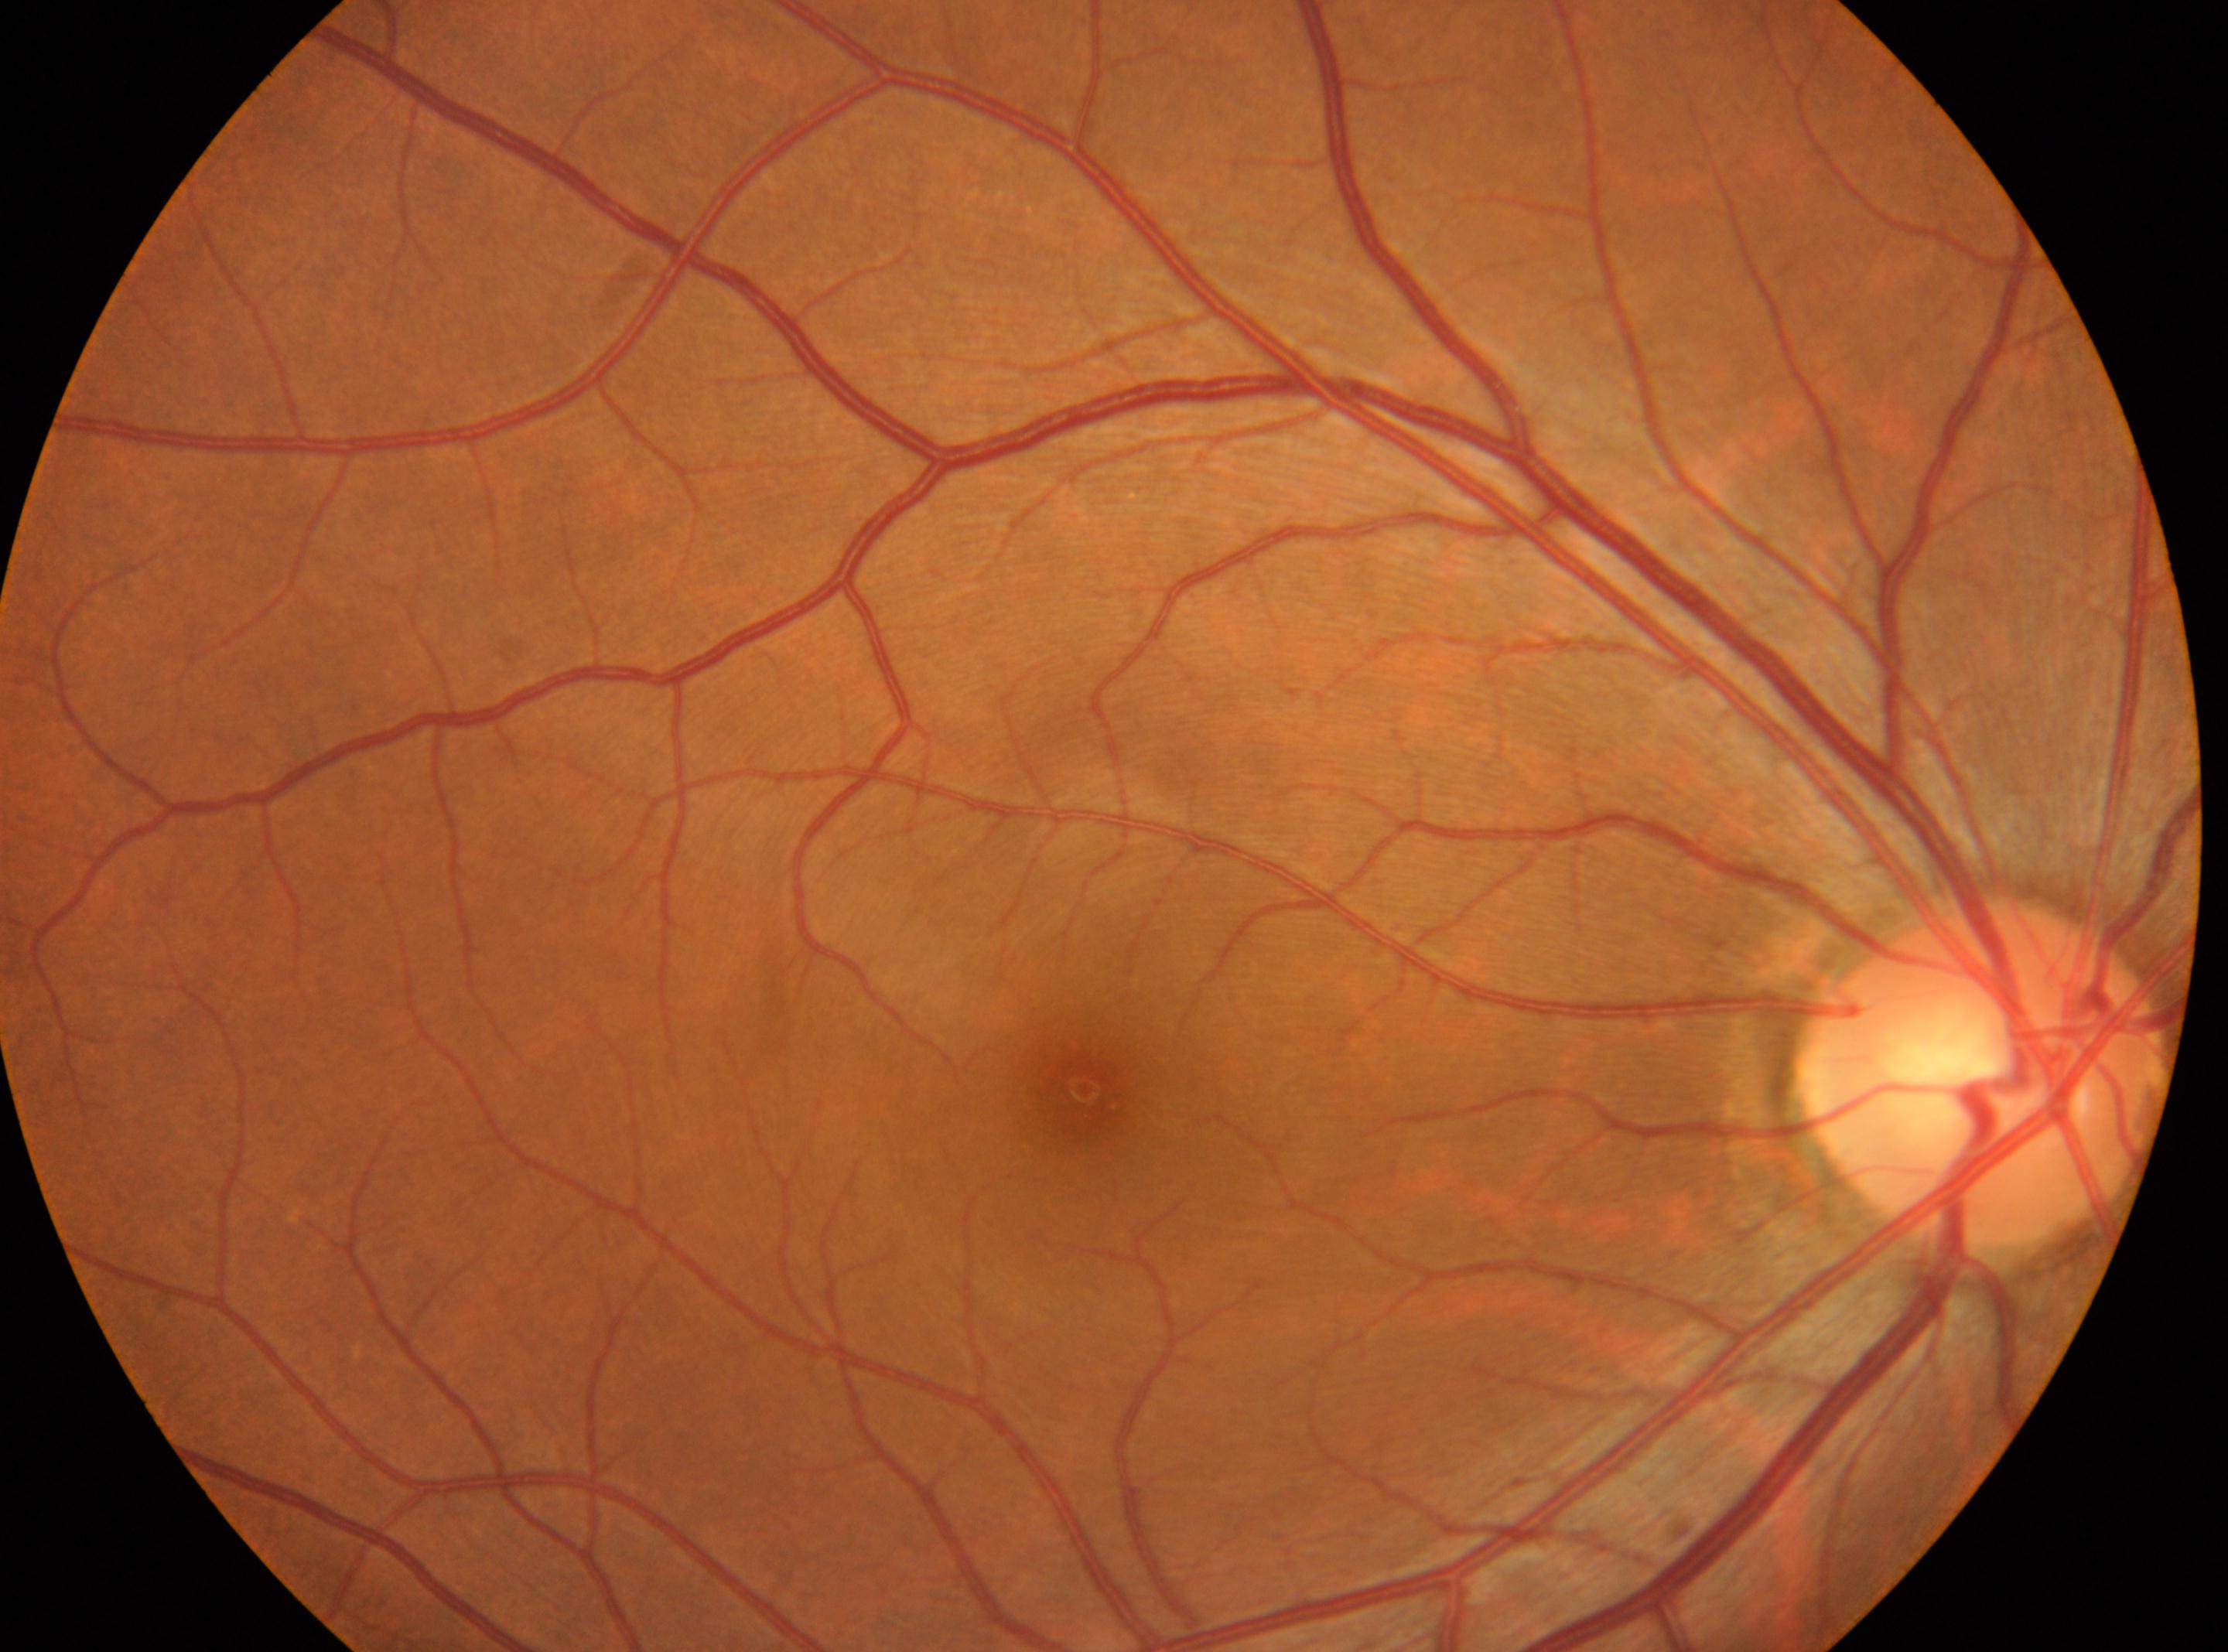 diabetic retinopathy: grade 0; foveal center: x=1085, y=1089; optic disk: x=1978, y=1072; eye: OD.